Color fundus image; Forus 3Nethra Classic; 2048 by 1536 pixels:
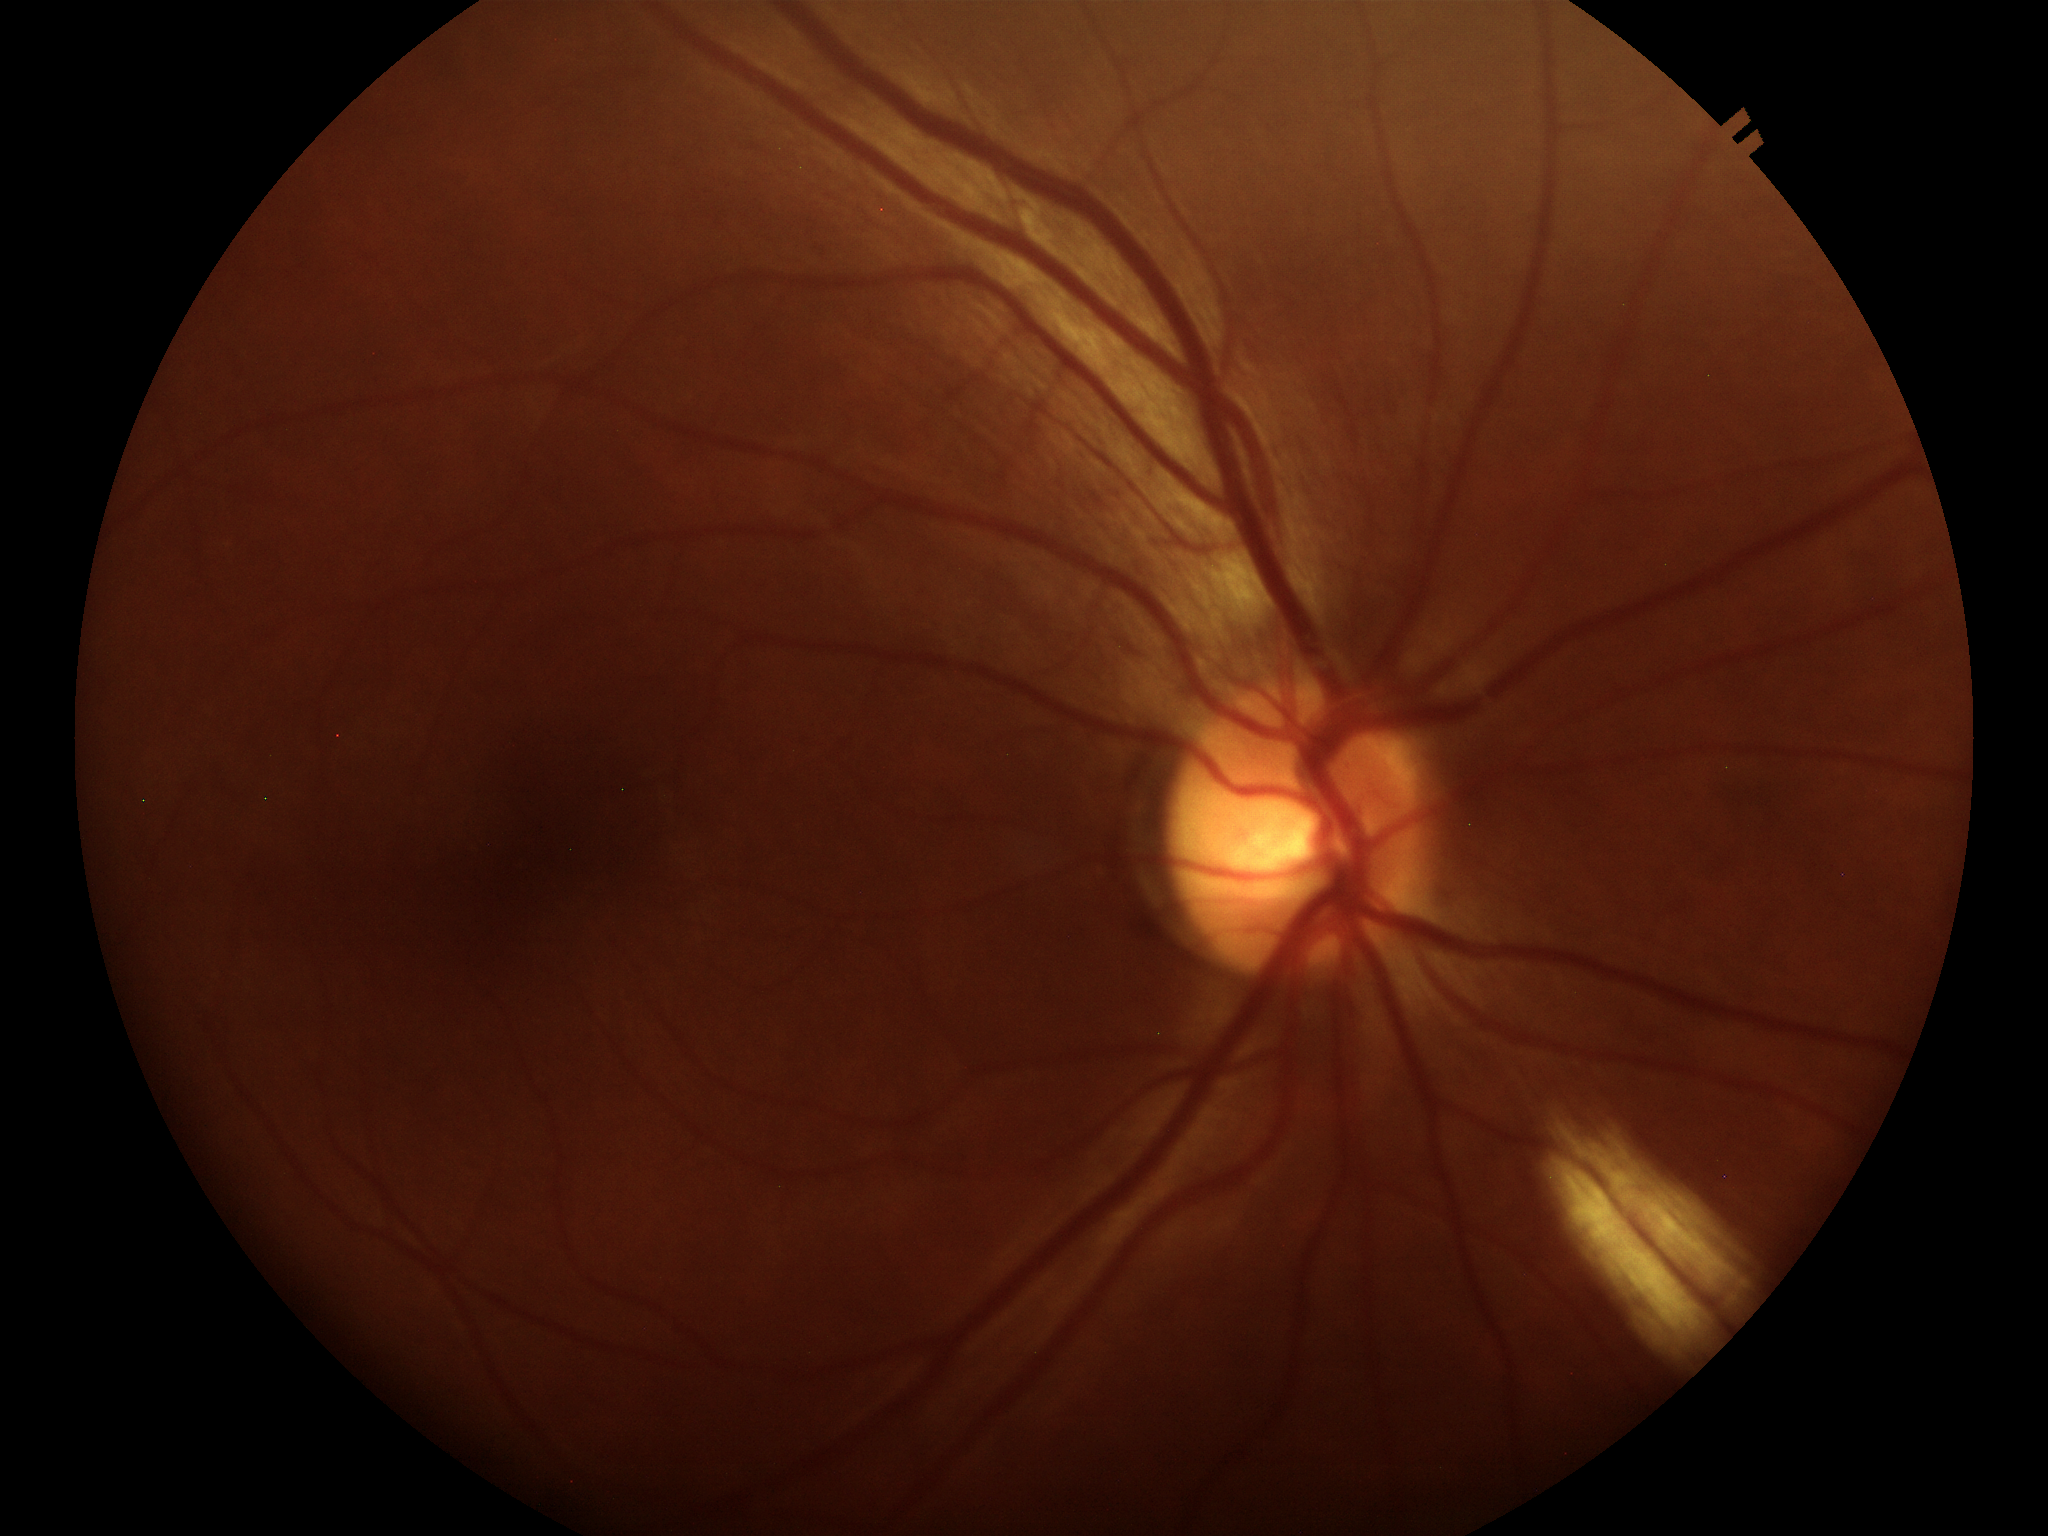 • Glaucoma screening impression · not suspect
• area cup-disc ratio · 0.28
• vertical cup-to-disc ratio · 0.51